Remidio Fundus on Phone (FOP) camera. 1659 x 2212 pixels. Fundus photo:
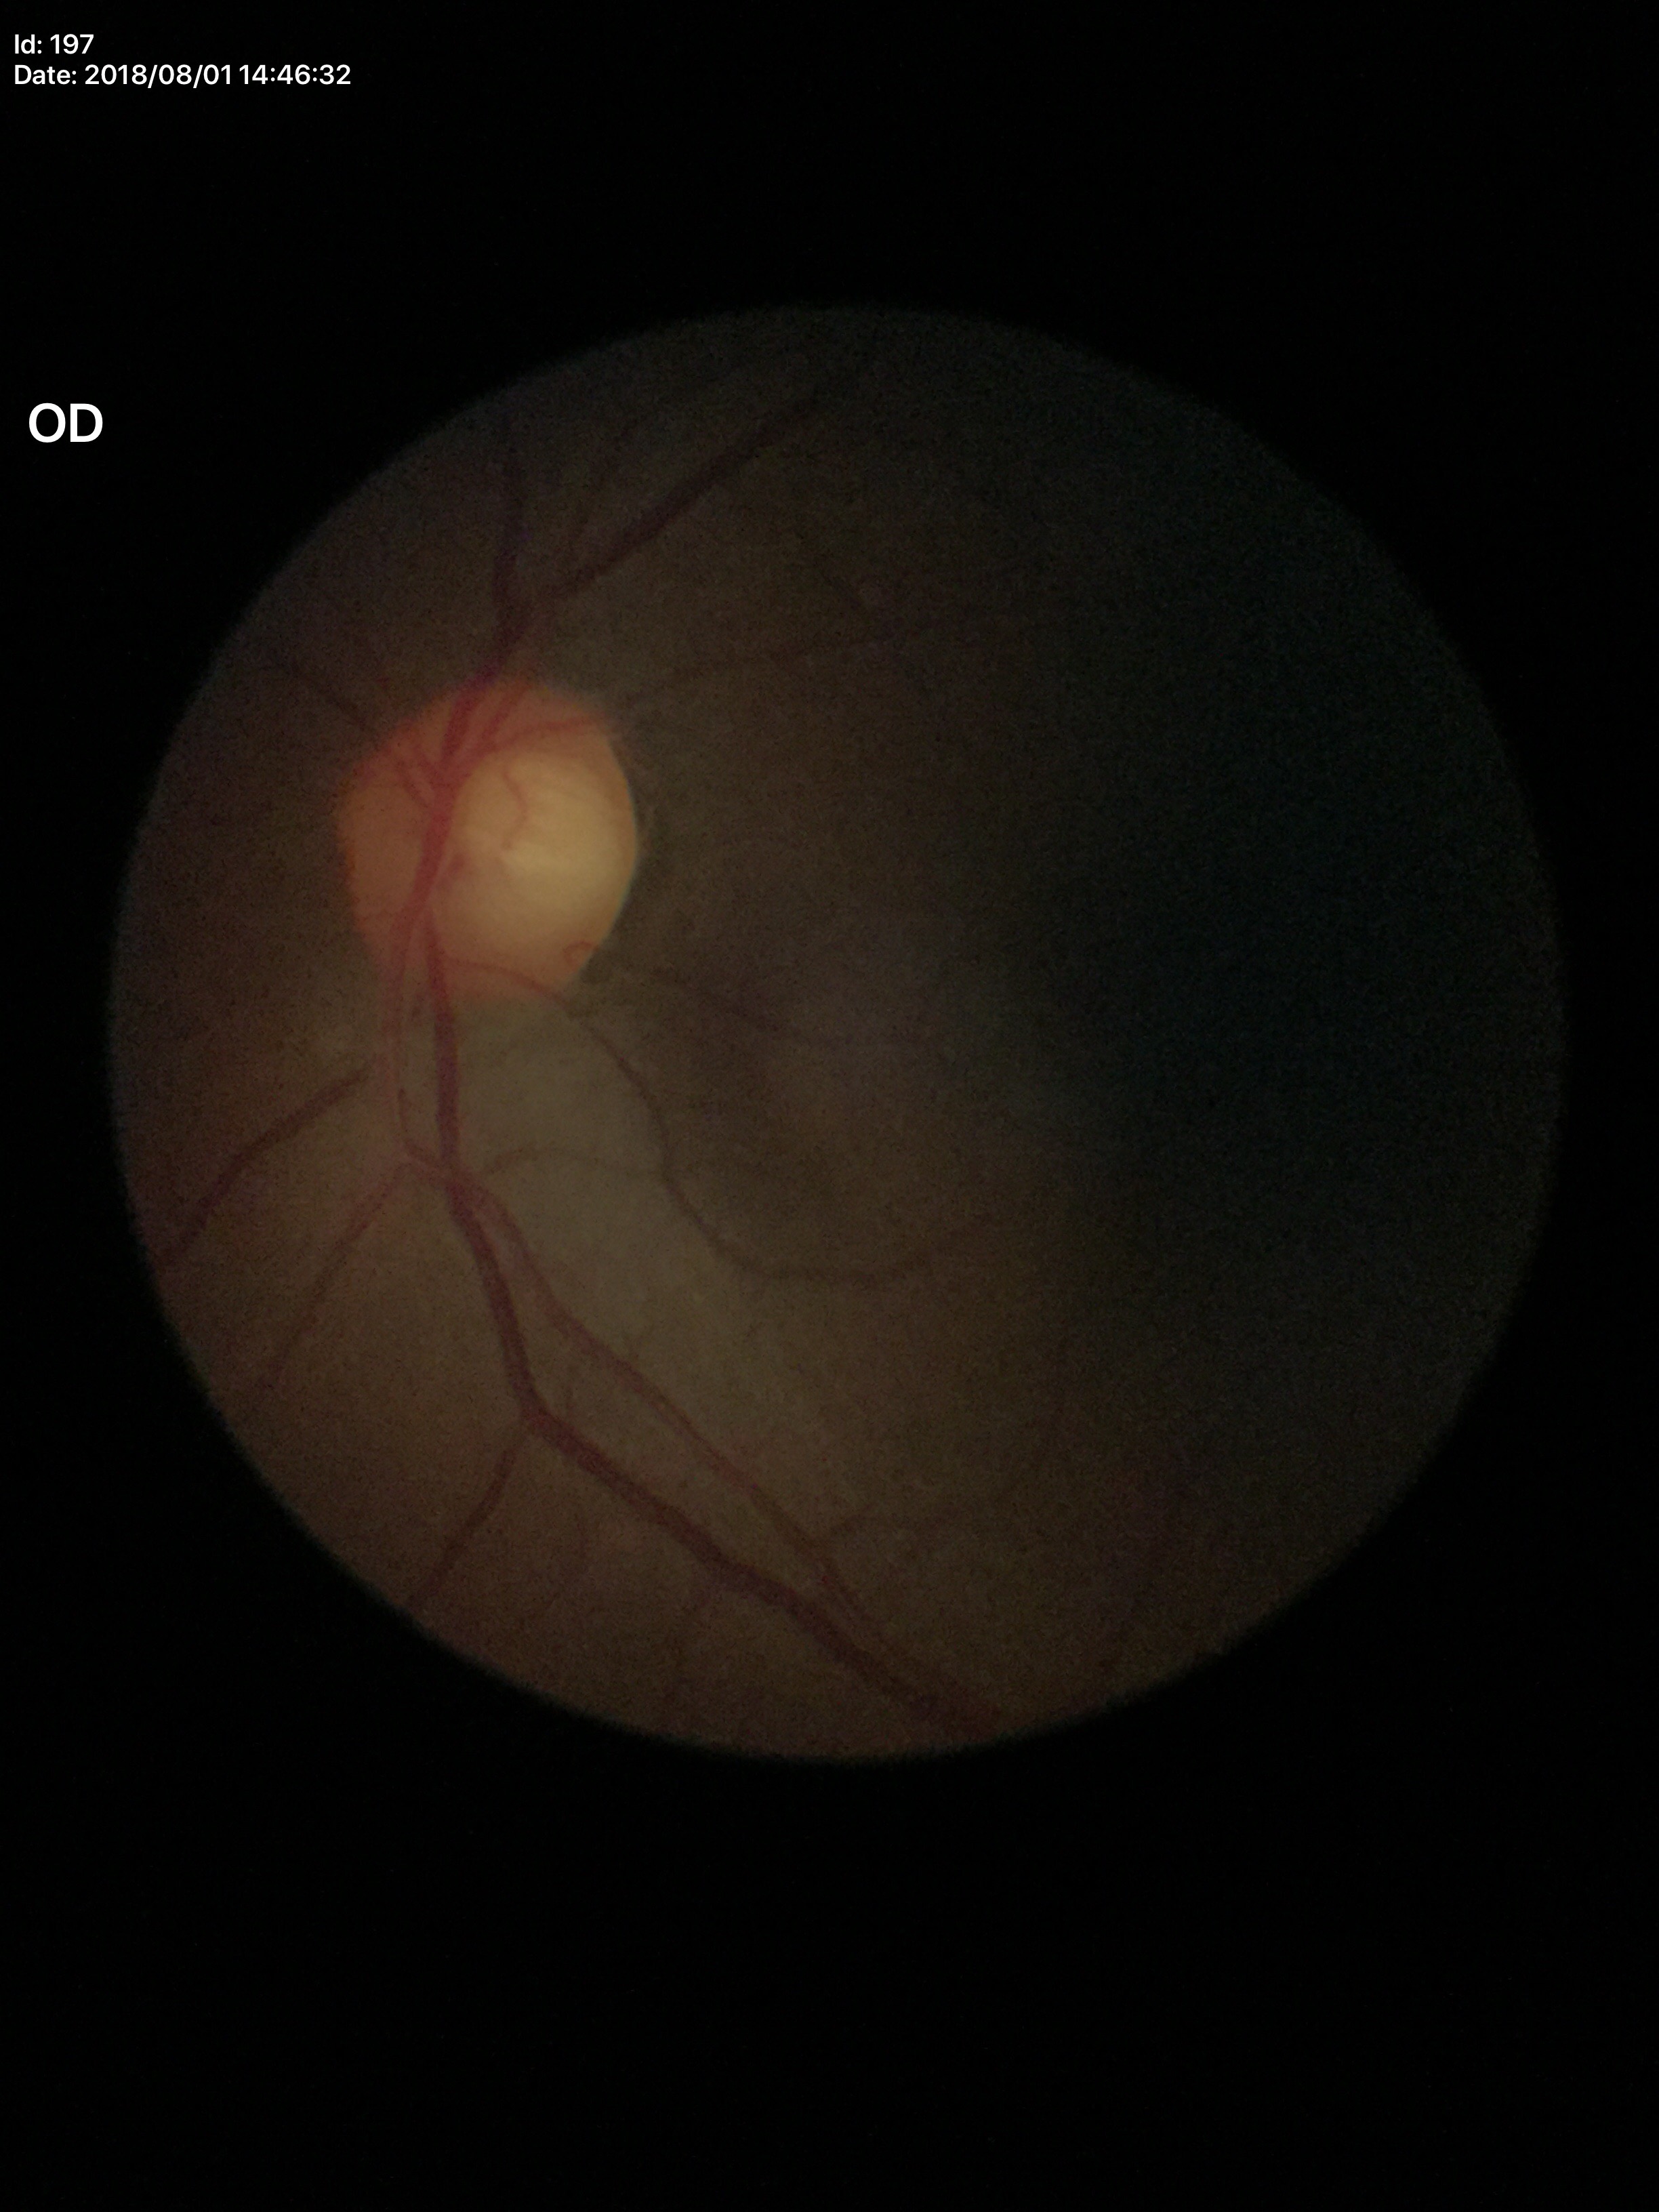
Glaucoma-suspect optic disc appearance. Vertical cup-disc ratio (VCDR) of 0.65.